CFP. 45° field of view.
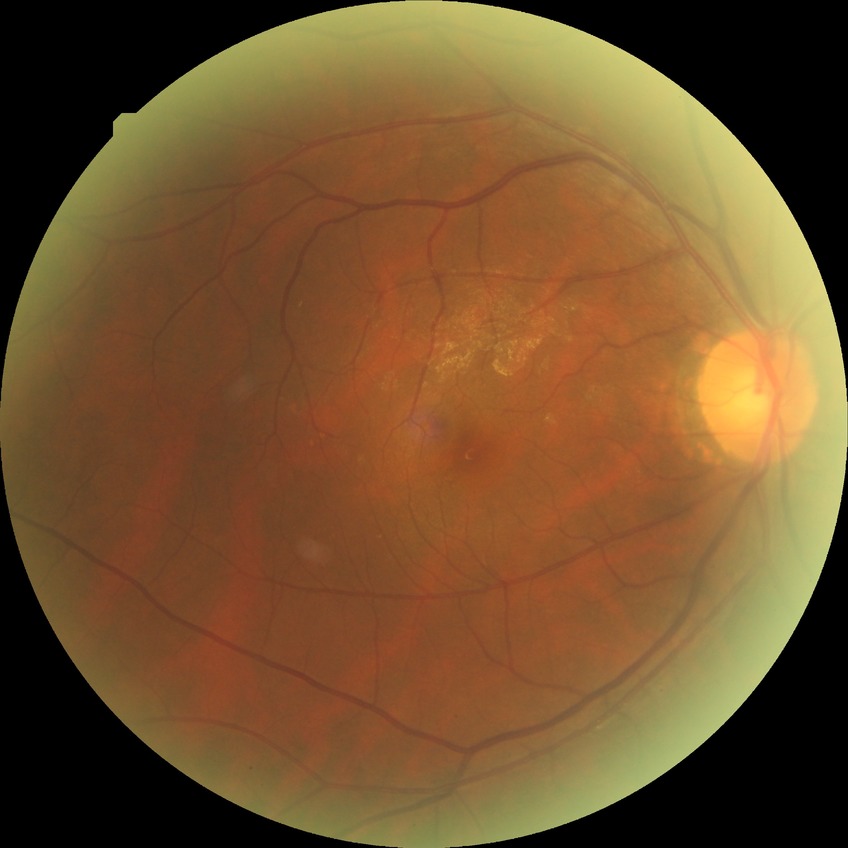
Modified Davis classification: no diabetic retinopathy.